768x576px: 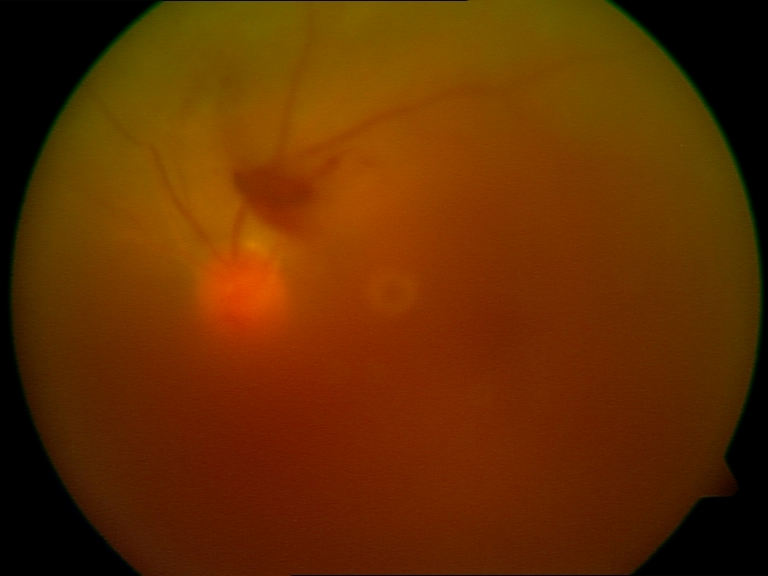

Image quality: significantly degraded.
Proliferative diabetic retinopathy: features suspicious.